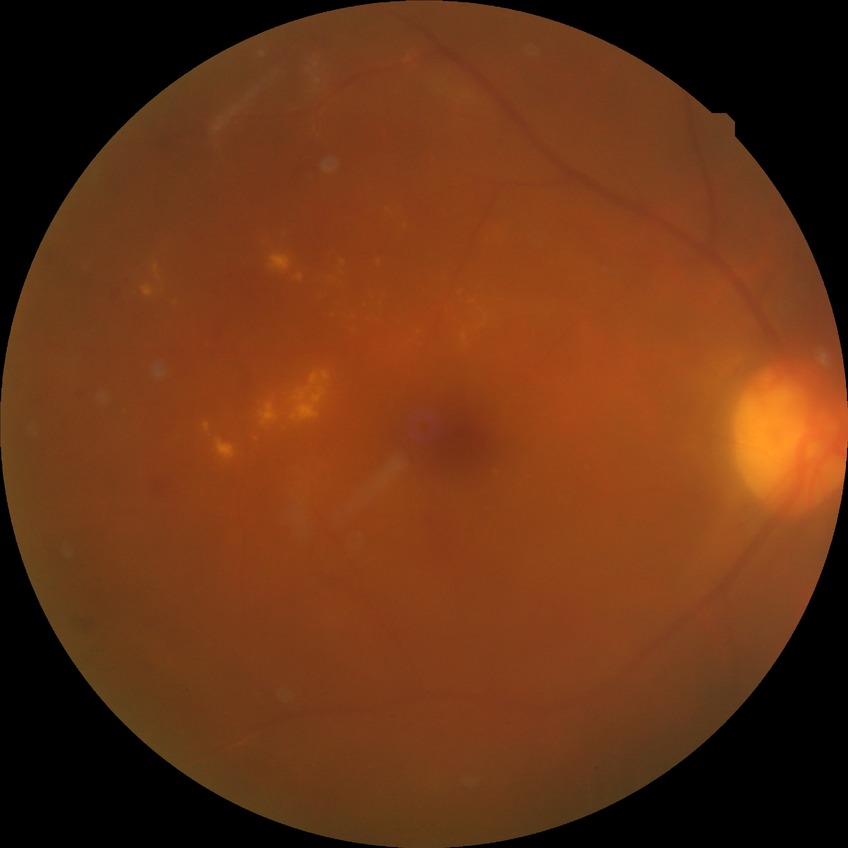 Diabetic retinopathy (DR): simple diabetic retinopathy (SDR).